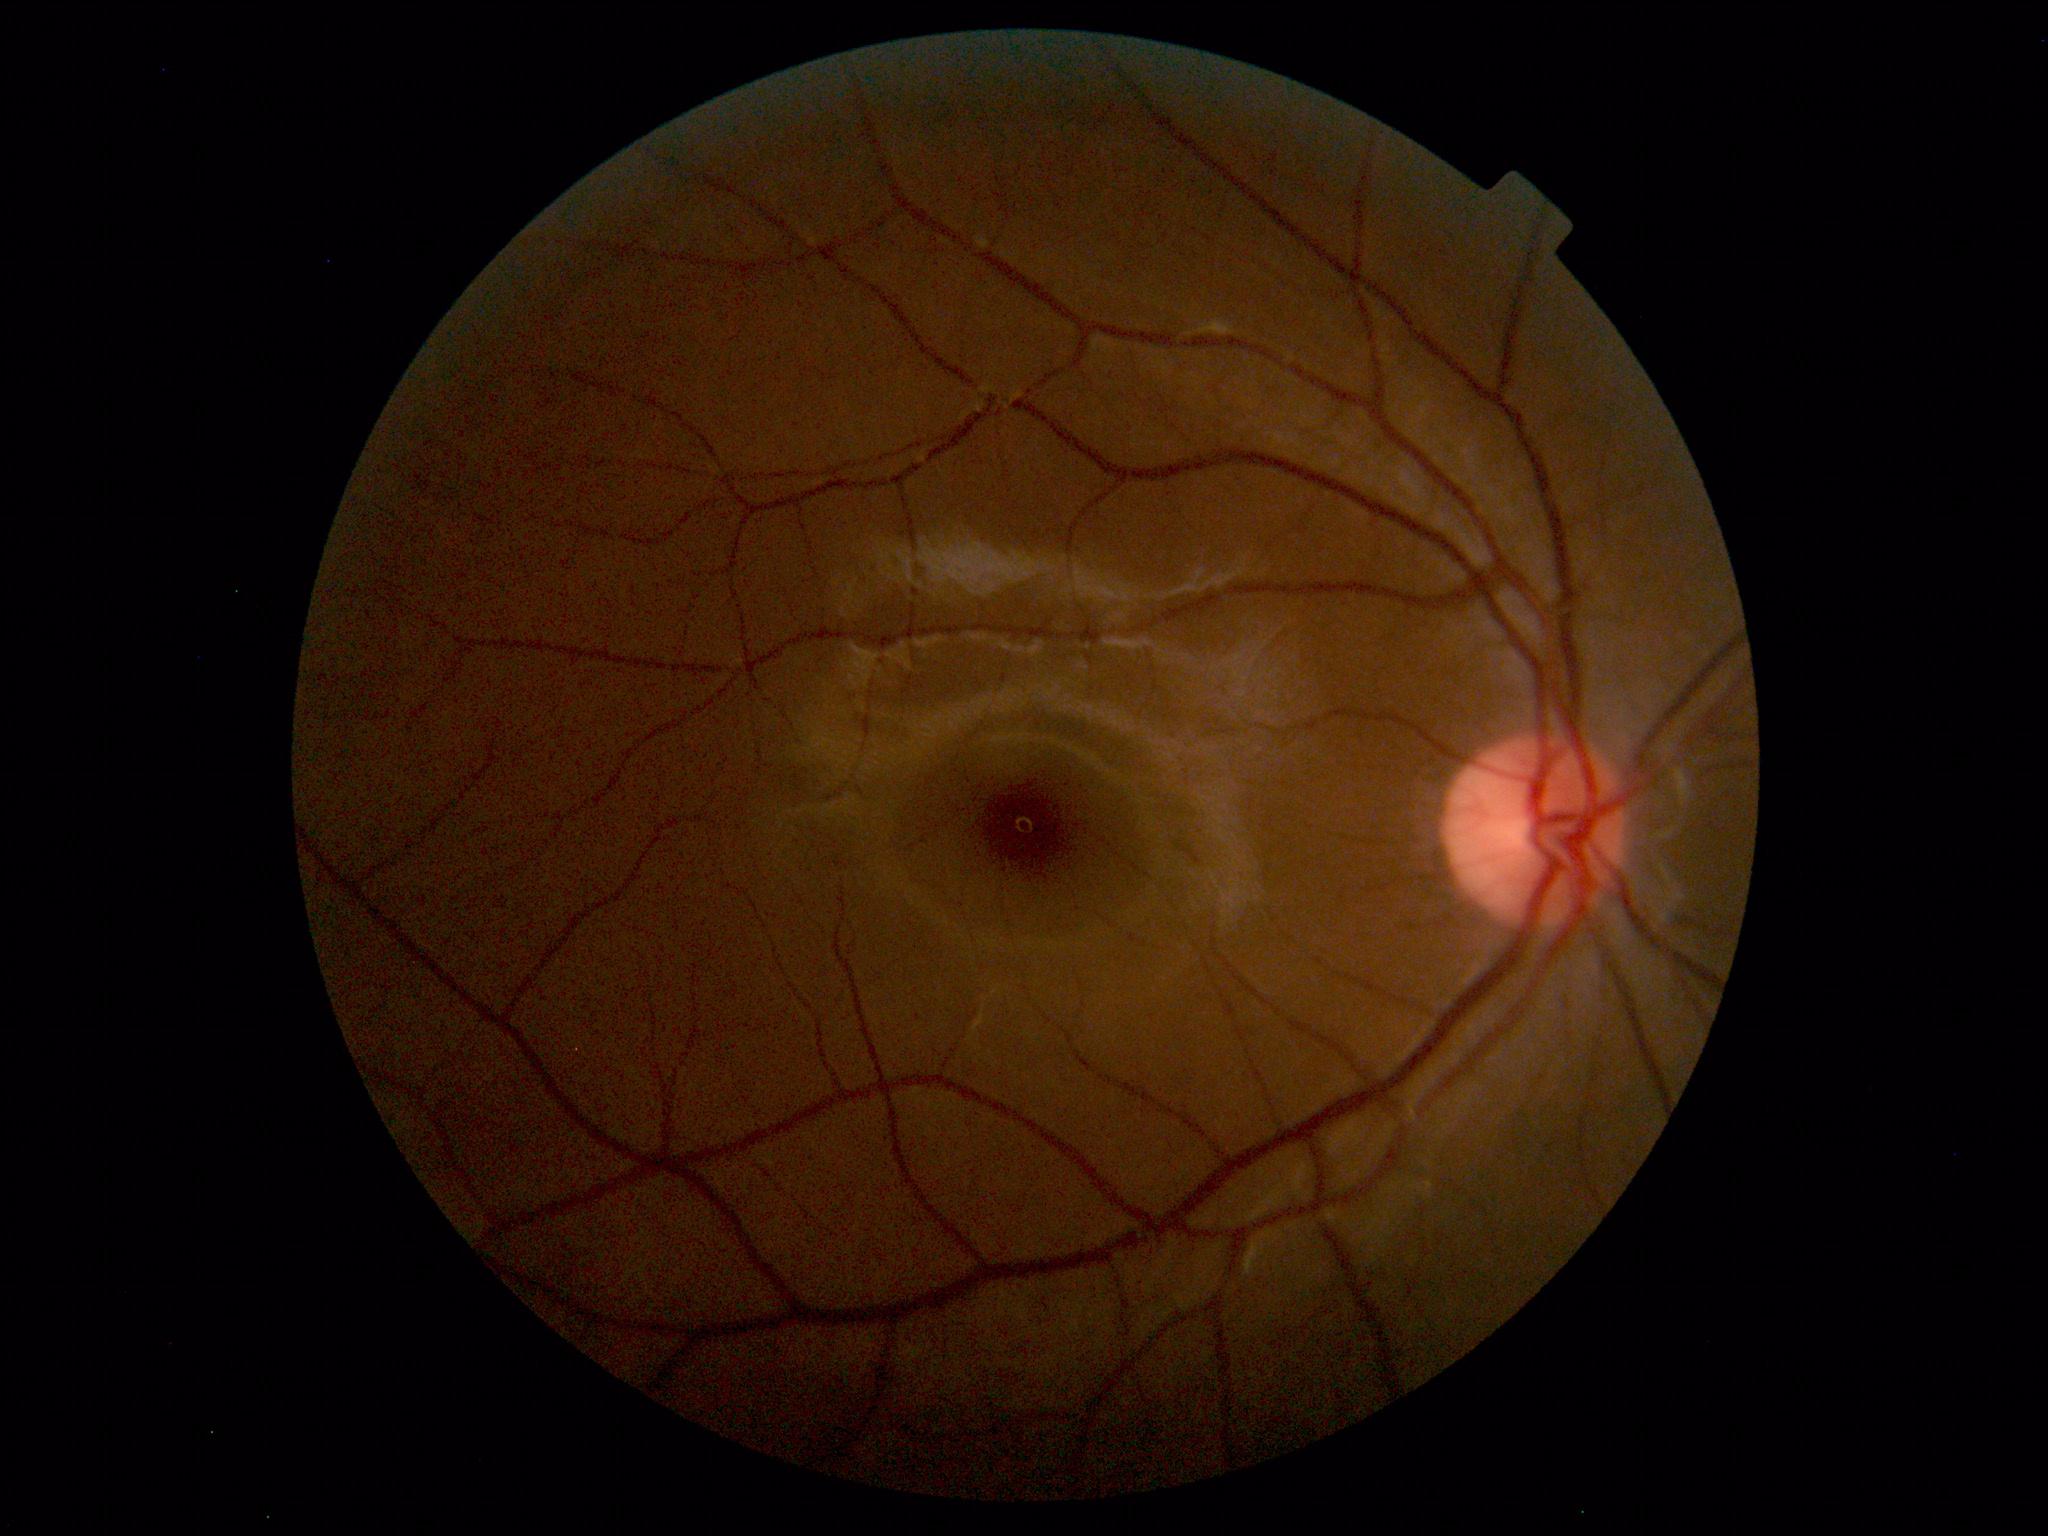
Normal color fundus photograph.